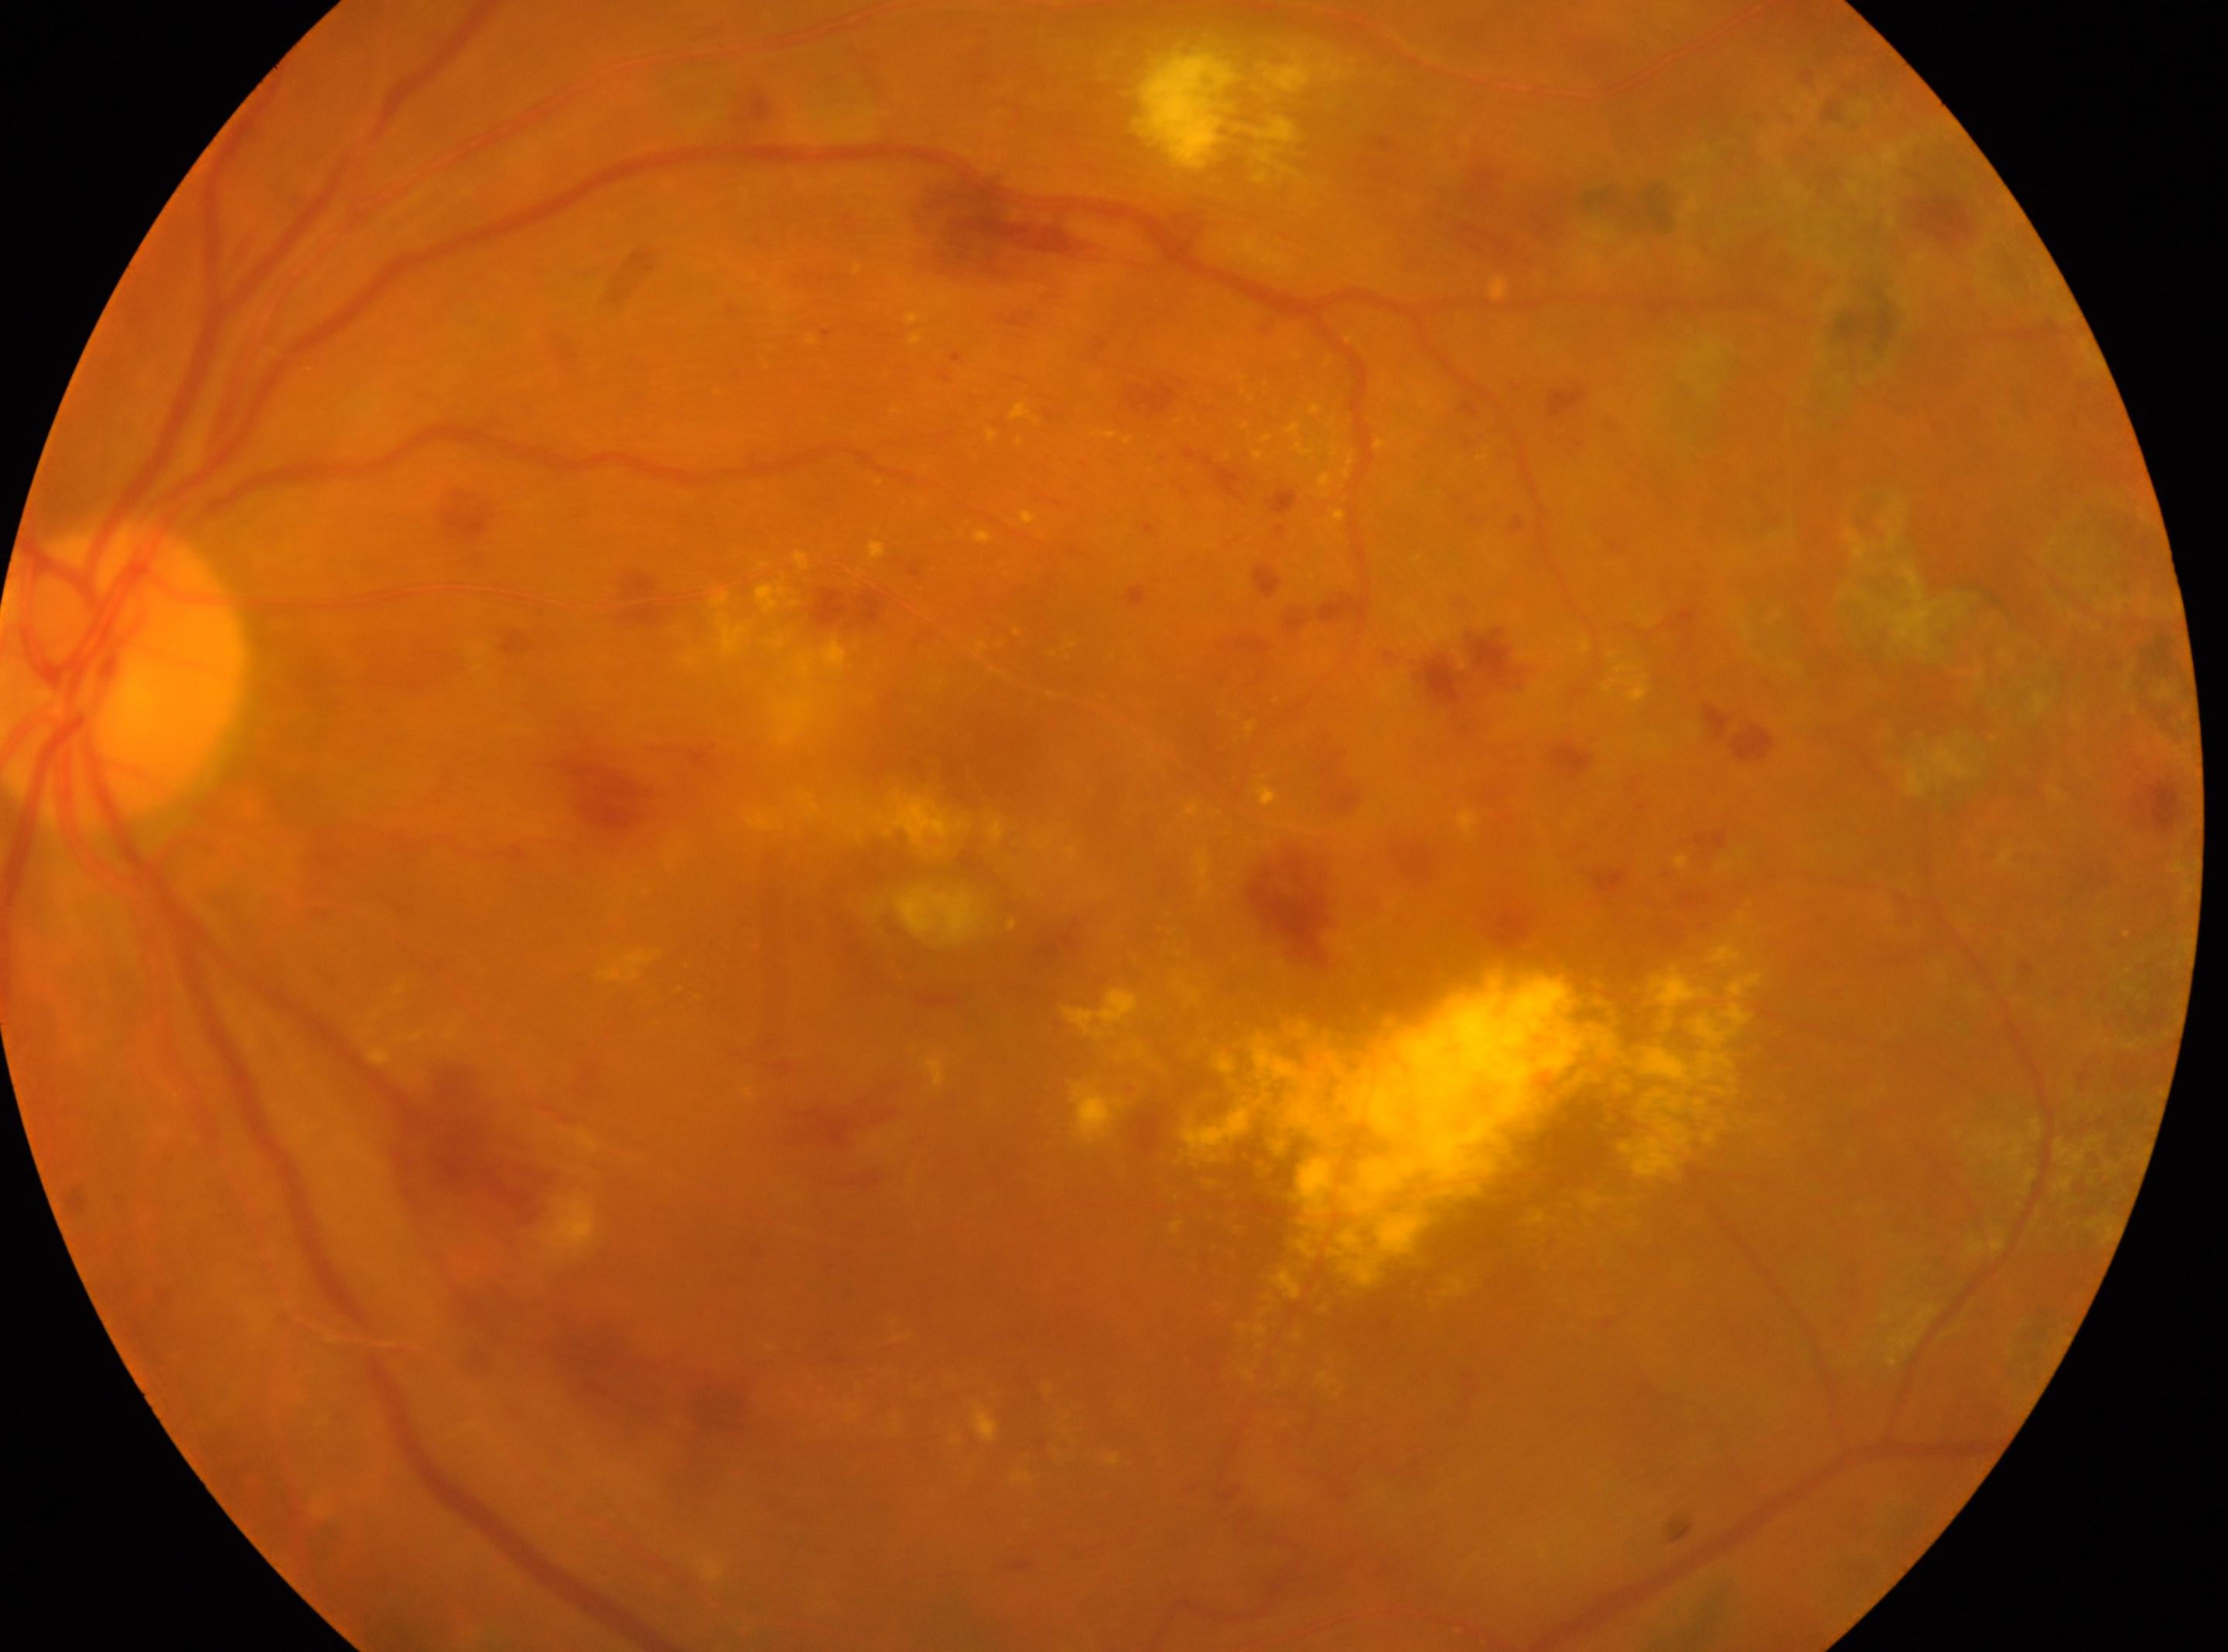 Q: Where is the optic disc?
A: (x=125, y=678)
Q: Diabetic retinopathy severity?
A: laser-treated DR, reclassified as severe NPDR (grade 3)
Q: Fovea center?
A: (x=964, y=908)
Q: What is the laterality?
A: the left eye